45 degree fundus photograph; color fundus photograph.
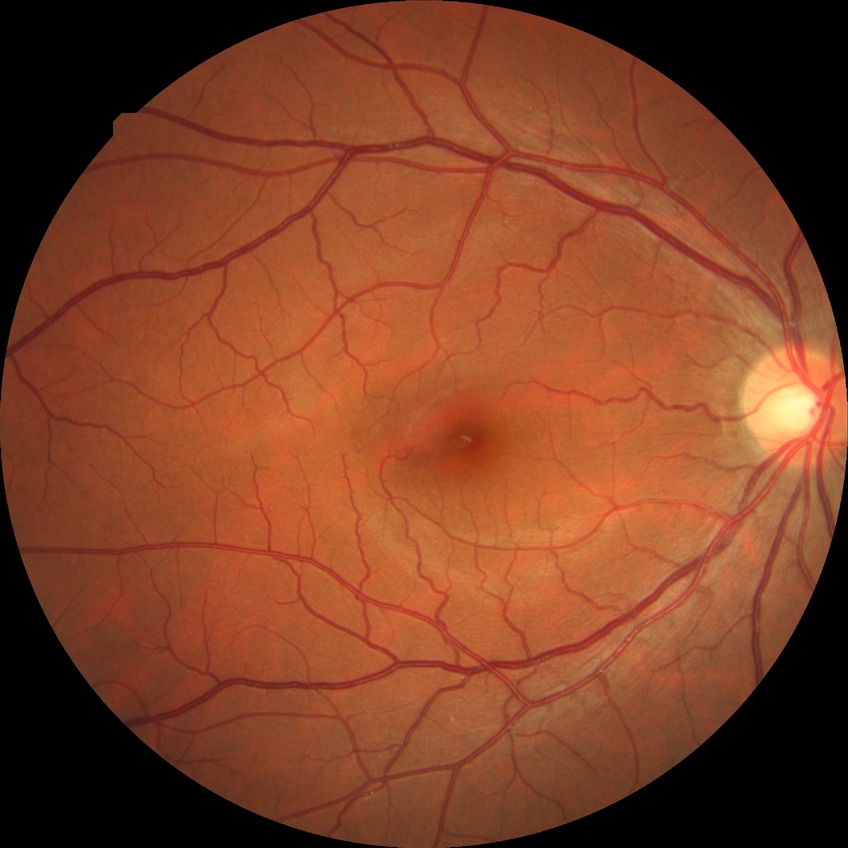
Modified Davis grading is no diabetic retinopathy.